Retinal fundus photograph
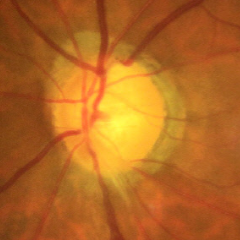

Glaucoma stage = early glaucomatous changes.